Nonmydriatic, NIDEK AFC-230, DR severity per modified Davis staging, 45° FOV, posterior pole photograph:
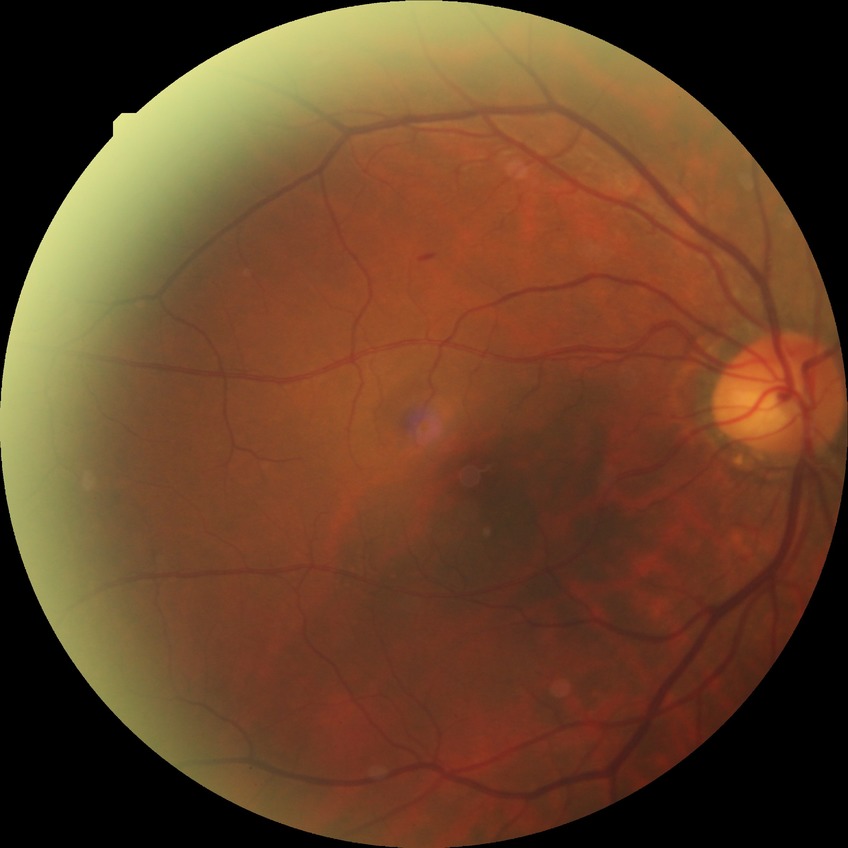
{
  "davis_grade": "simple diabetic retinopathy"
}